Wide-field fundus photograph from neonatal ROP screening — 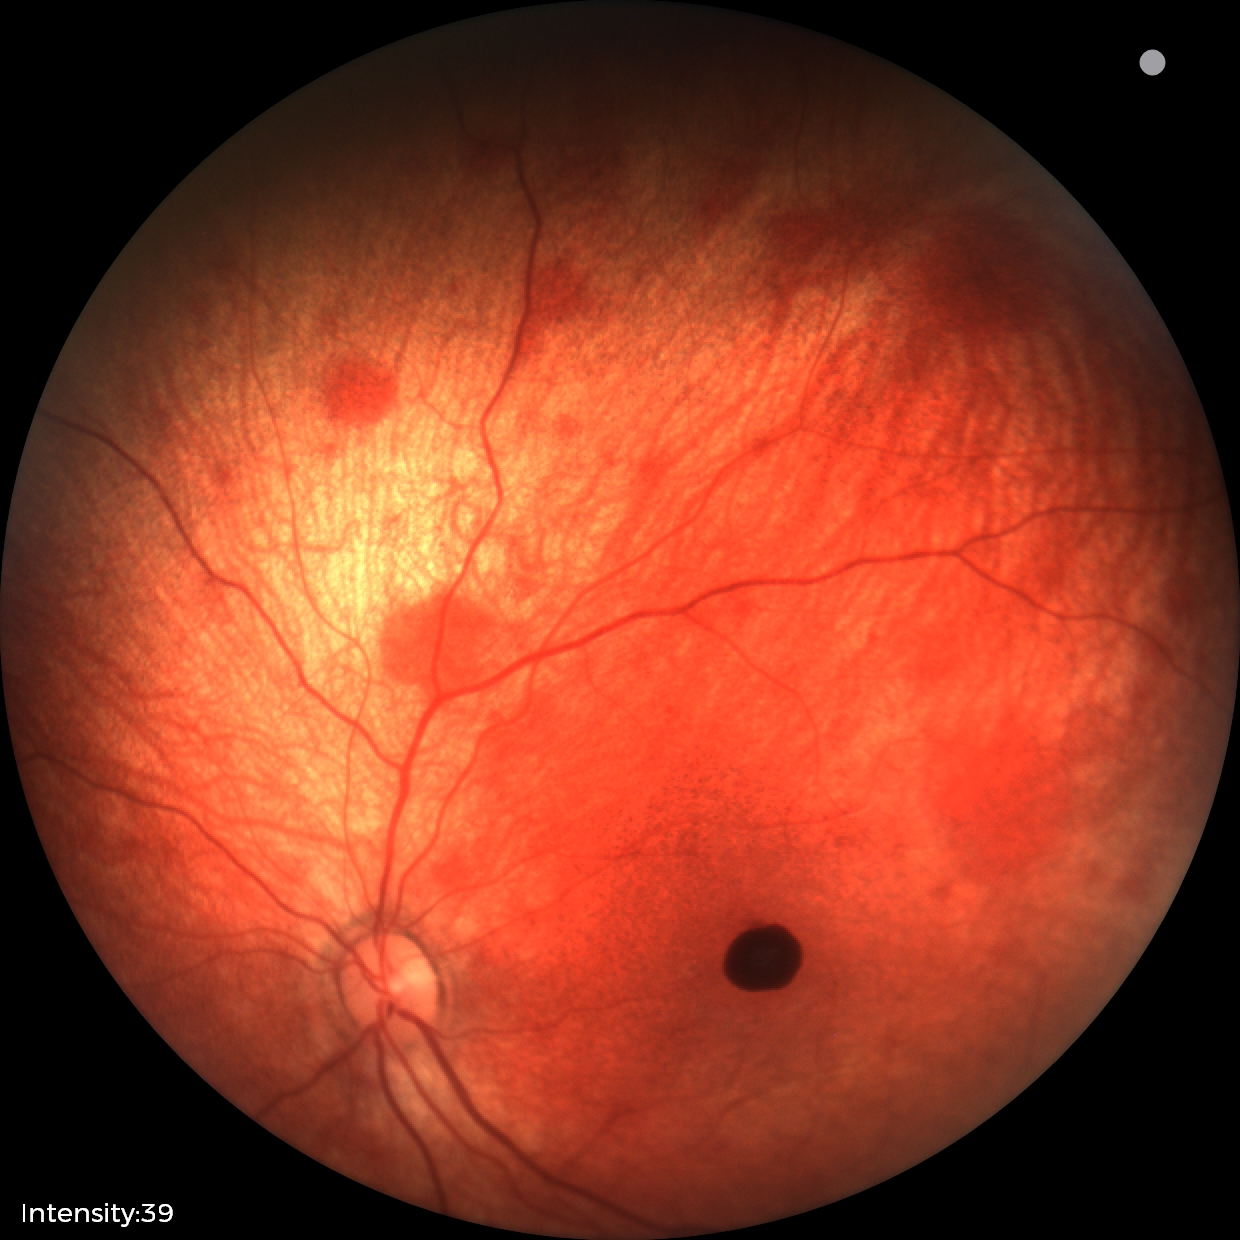
Diagnosis from this screening exam: retinal hemorrhages.